512x512 · color fundus photograph: 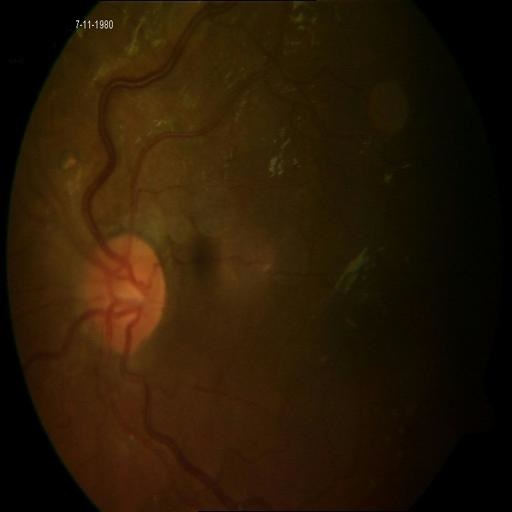

3 findings. Showing media haze (MH), tessellation (TSLN) & vasculitis (VS).